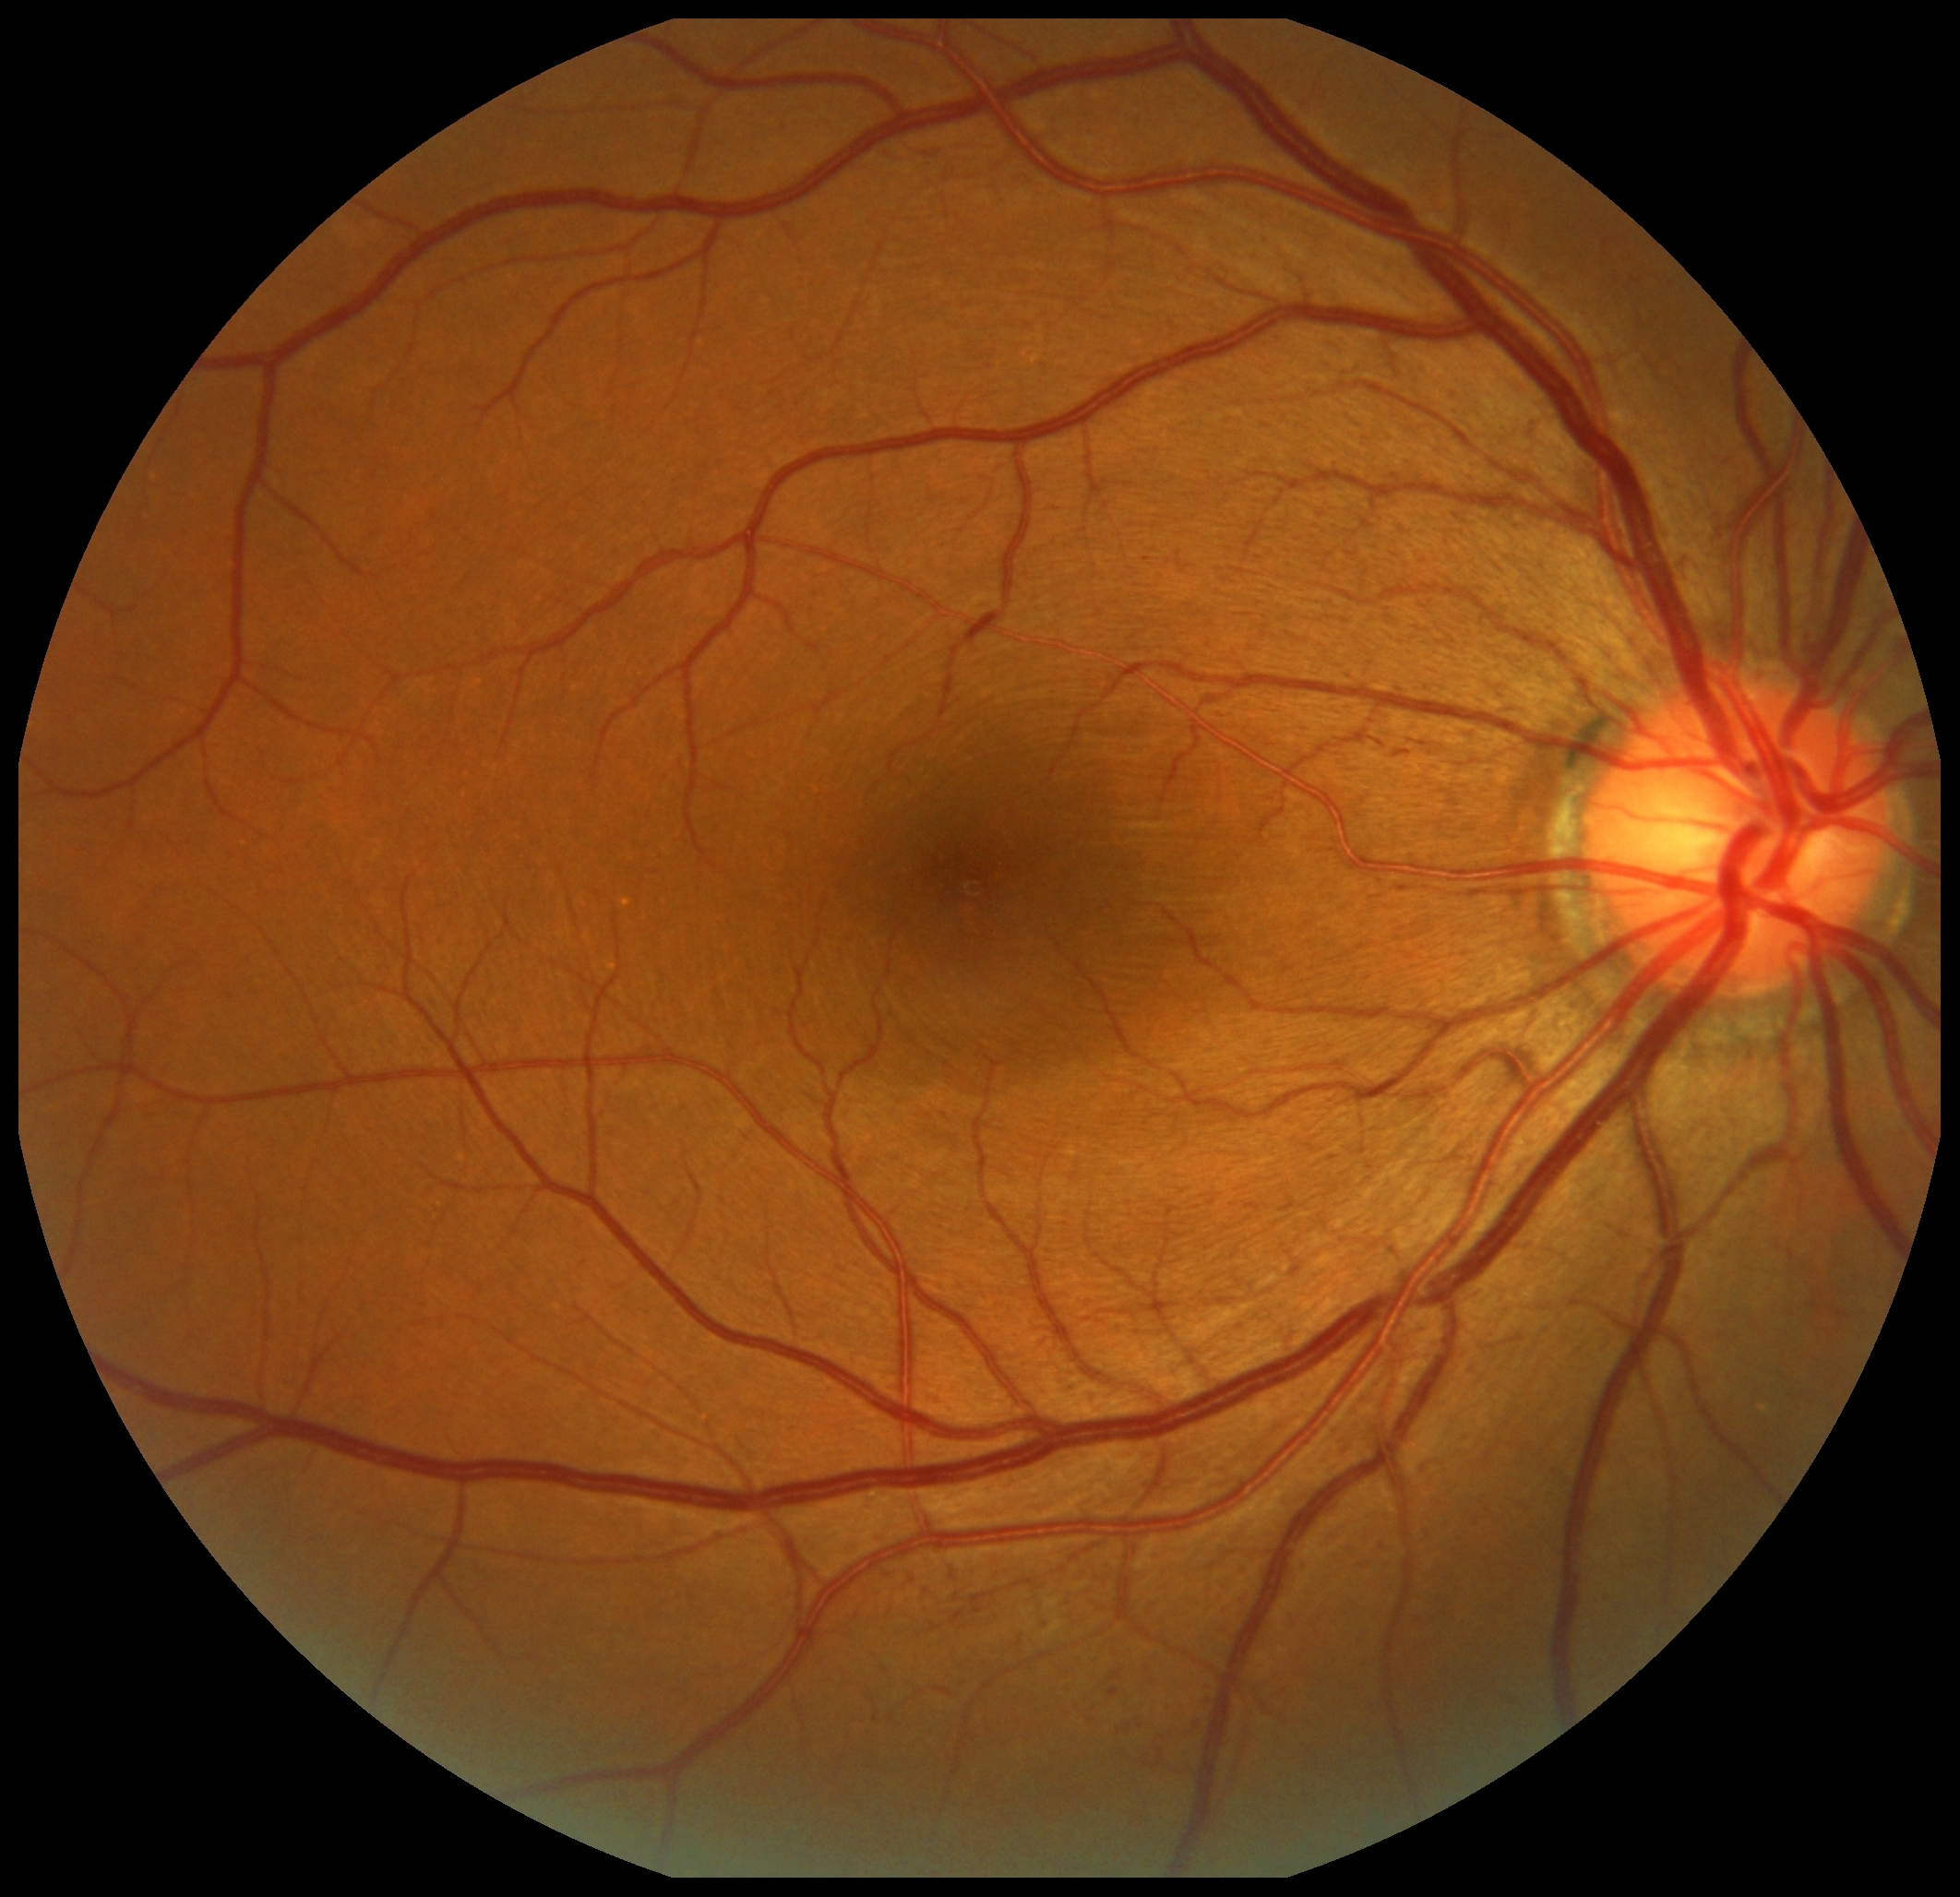 DR class: non-proliferative diabetic retinopathy.
DR grade is 2/4.